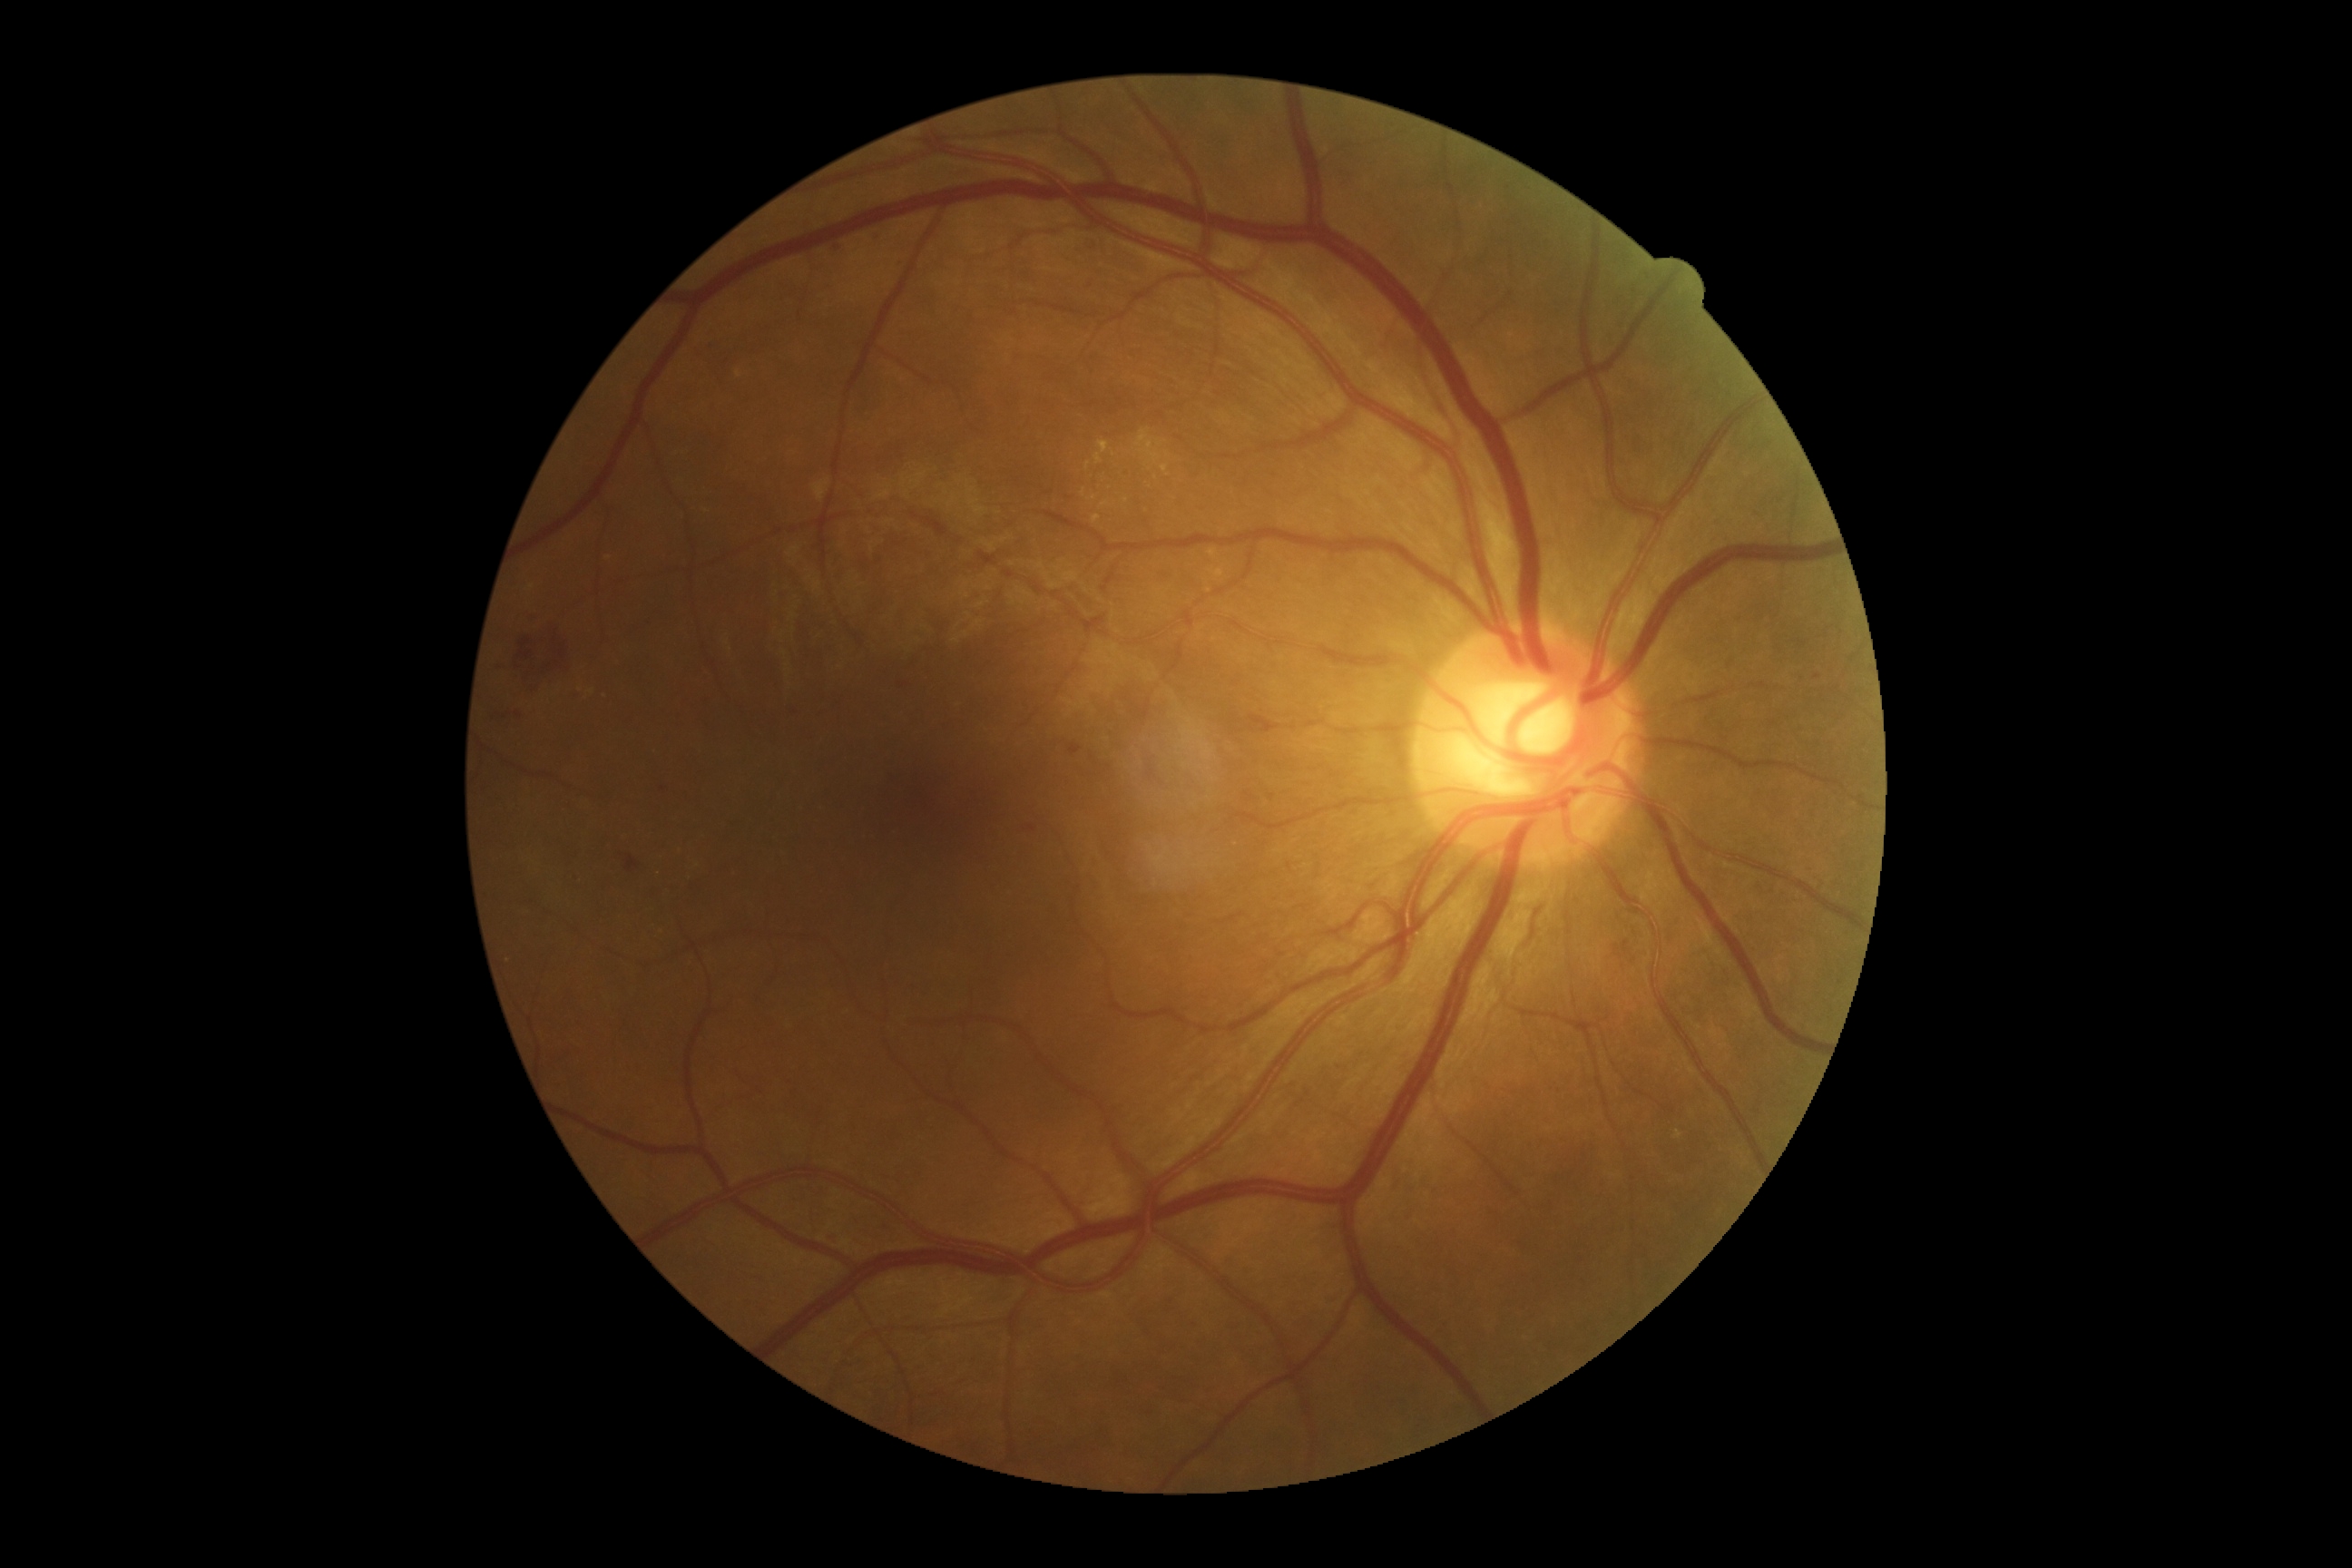

Findings:
* diabetic retinopathy grade: 2 (moderate NPDR)